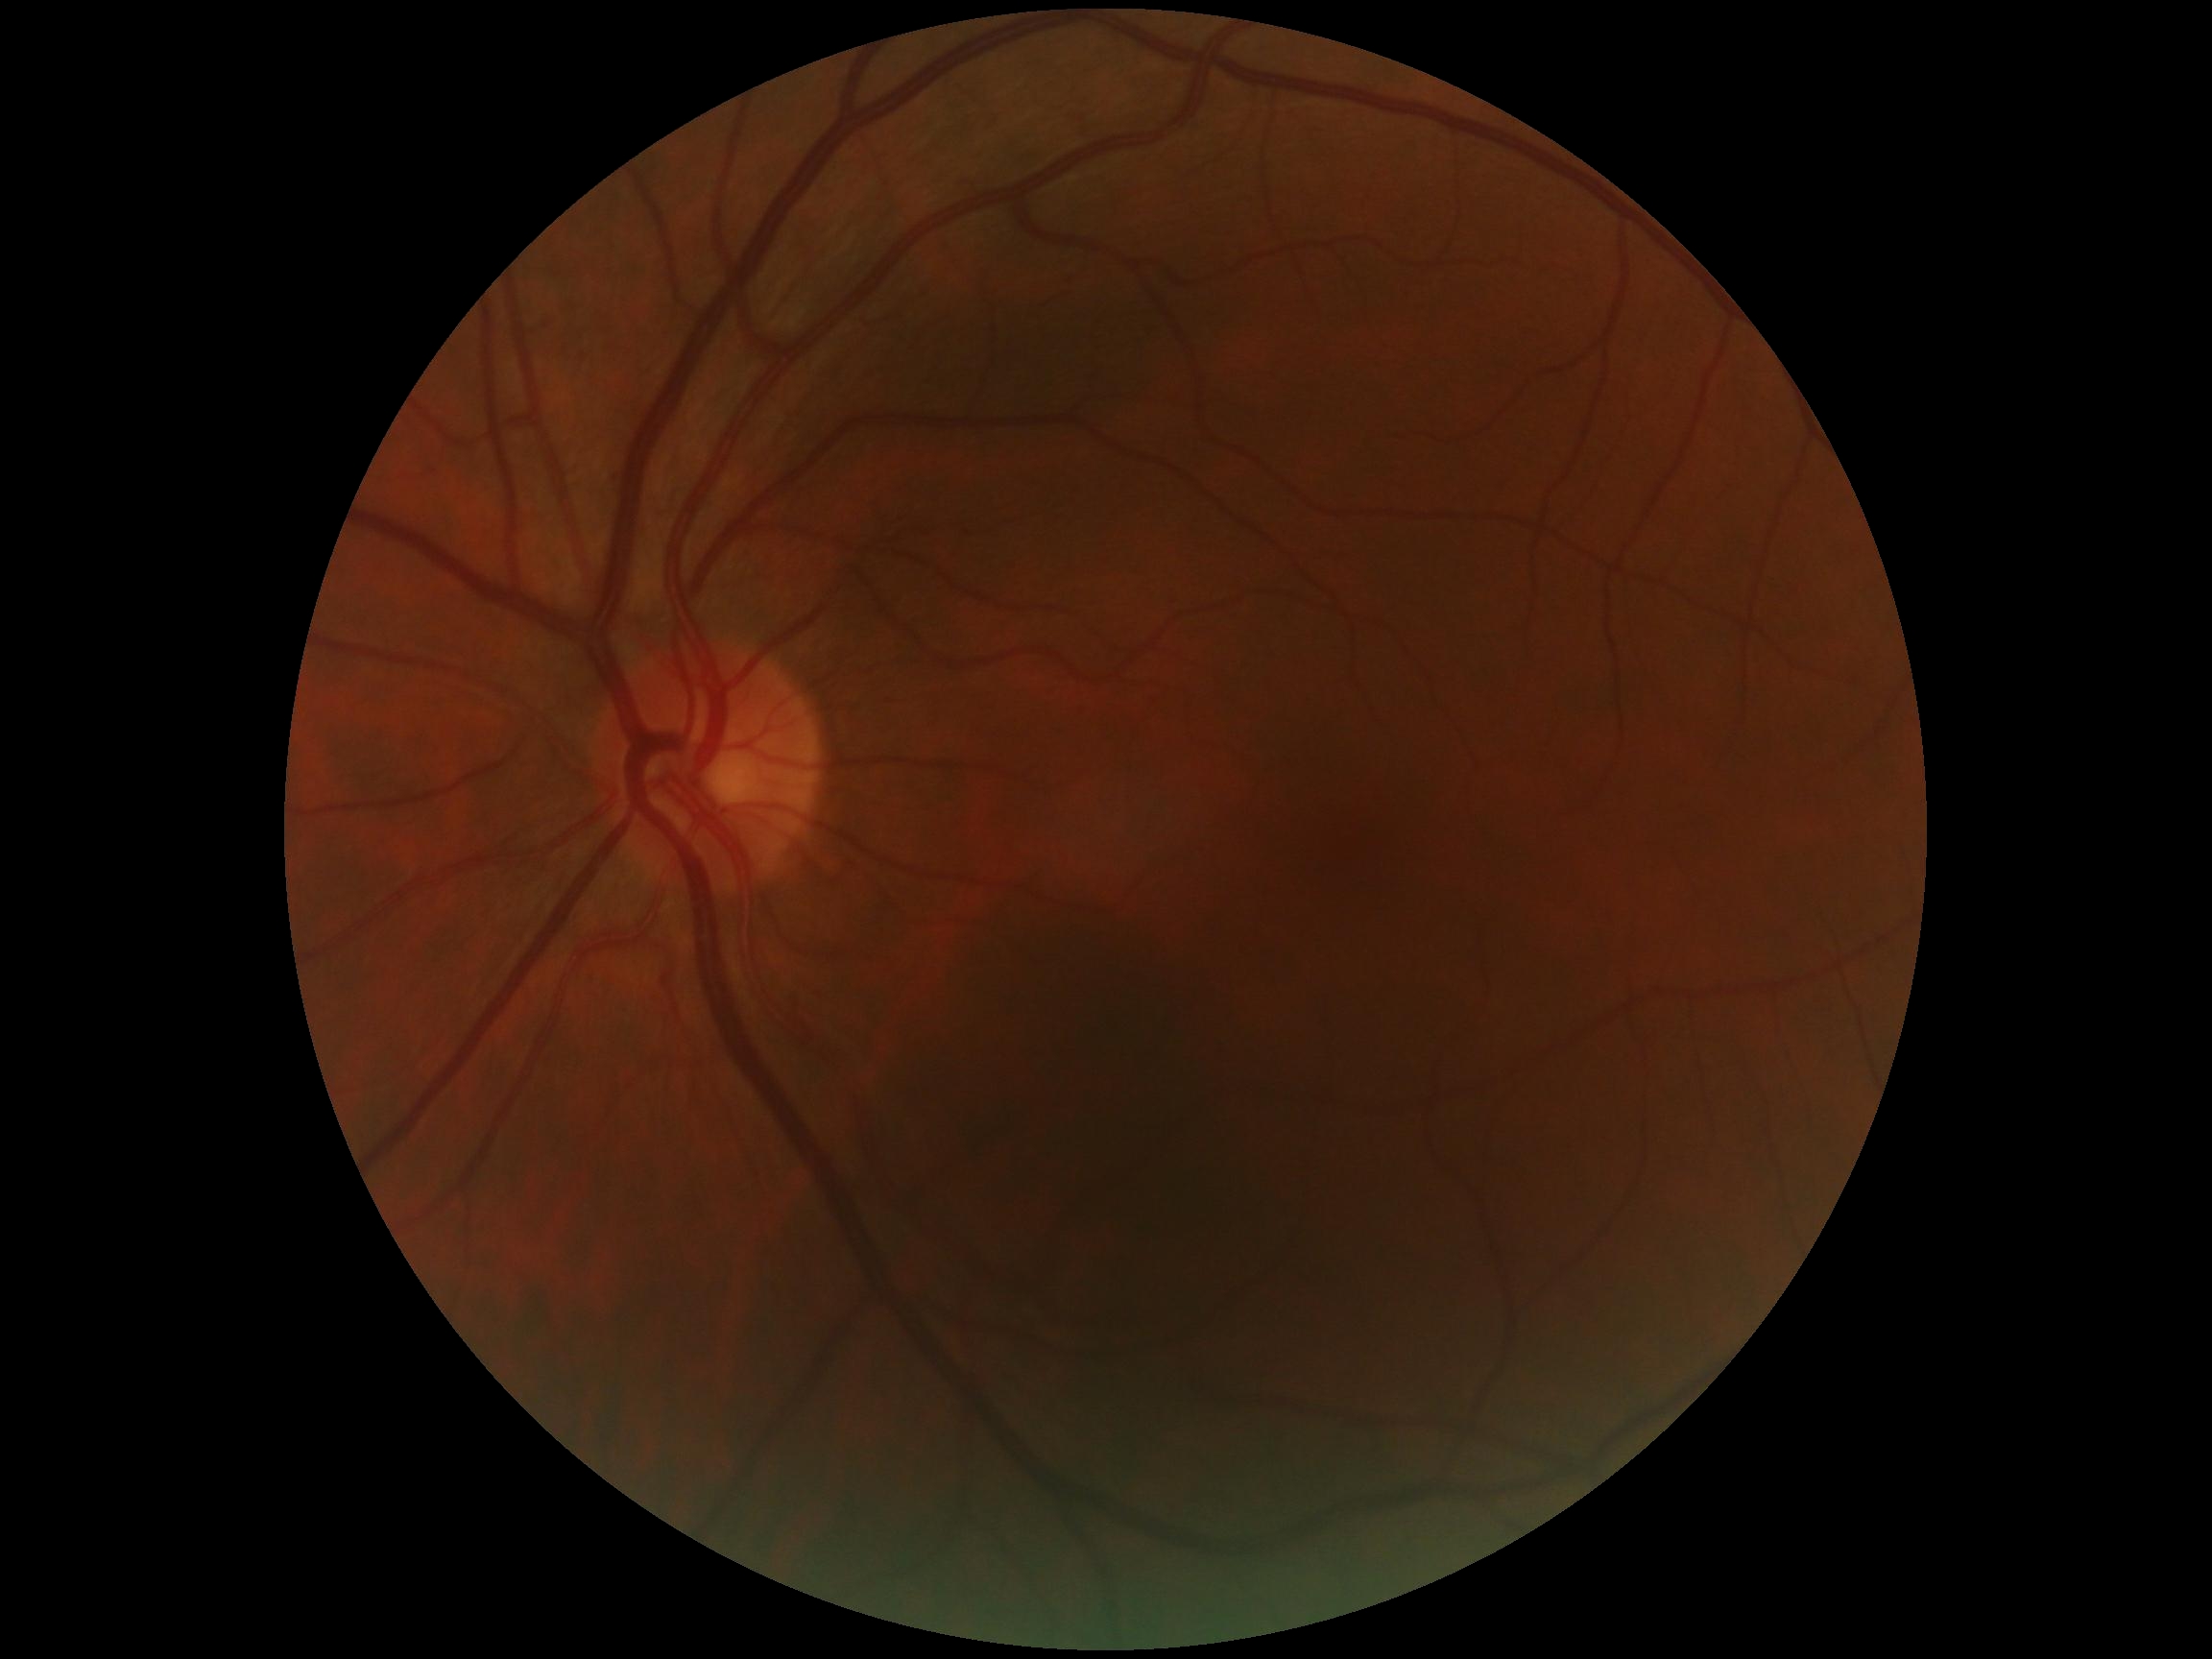

diabetic retinopathy (DR): grade 0 — no visible signs of diabetic retinopathy, DR impression: no DR findings.